Color fundus photograph — 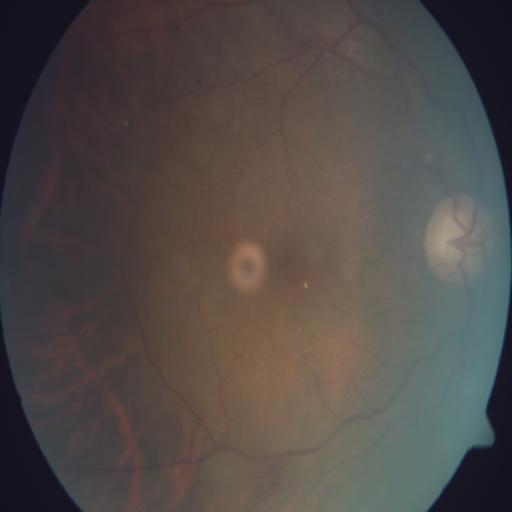
Diagnosis: tortuous vessels (TV).